2212 x 1659 pixels.
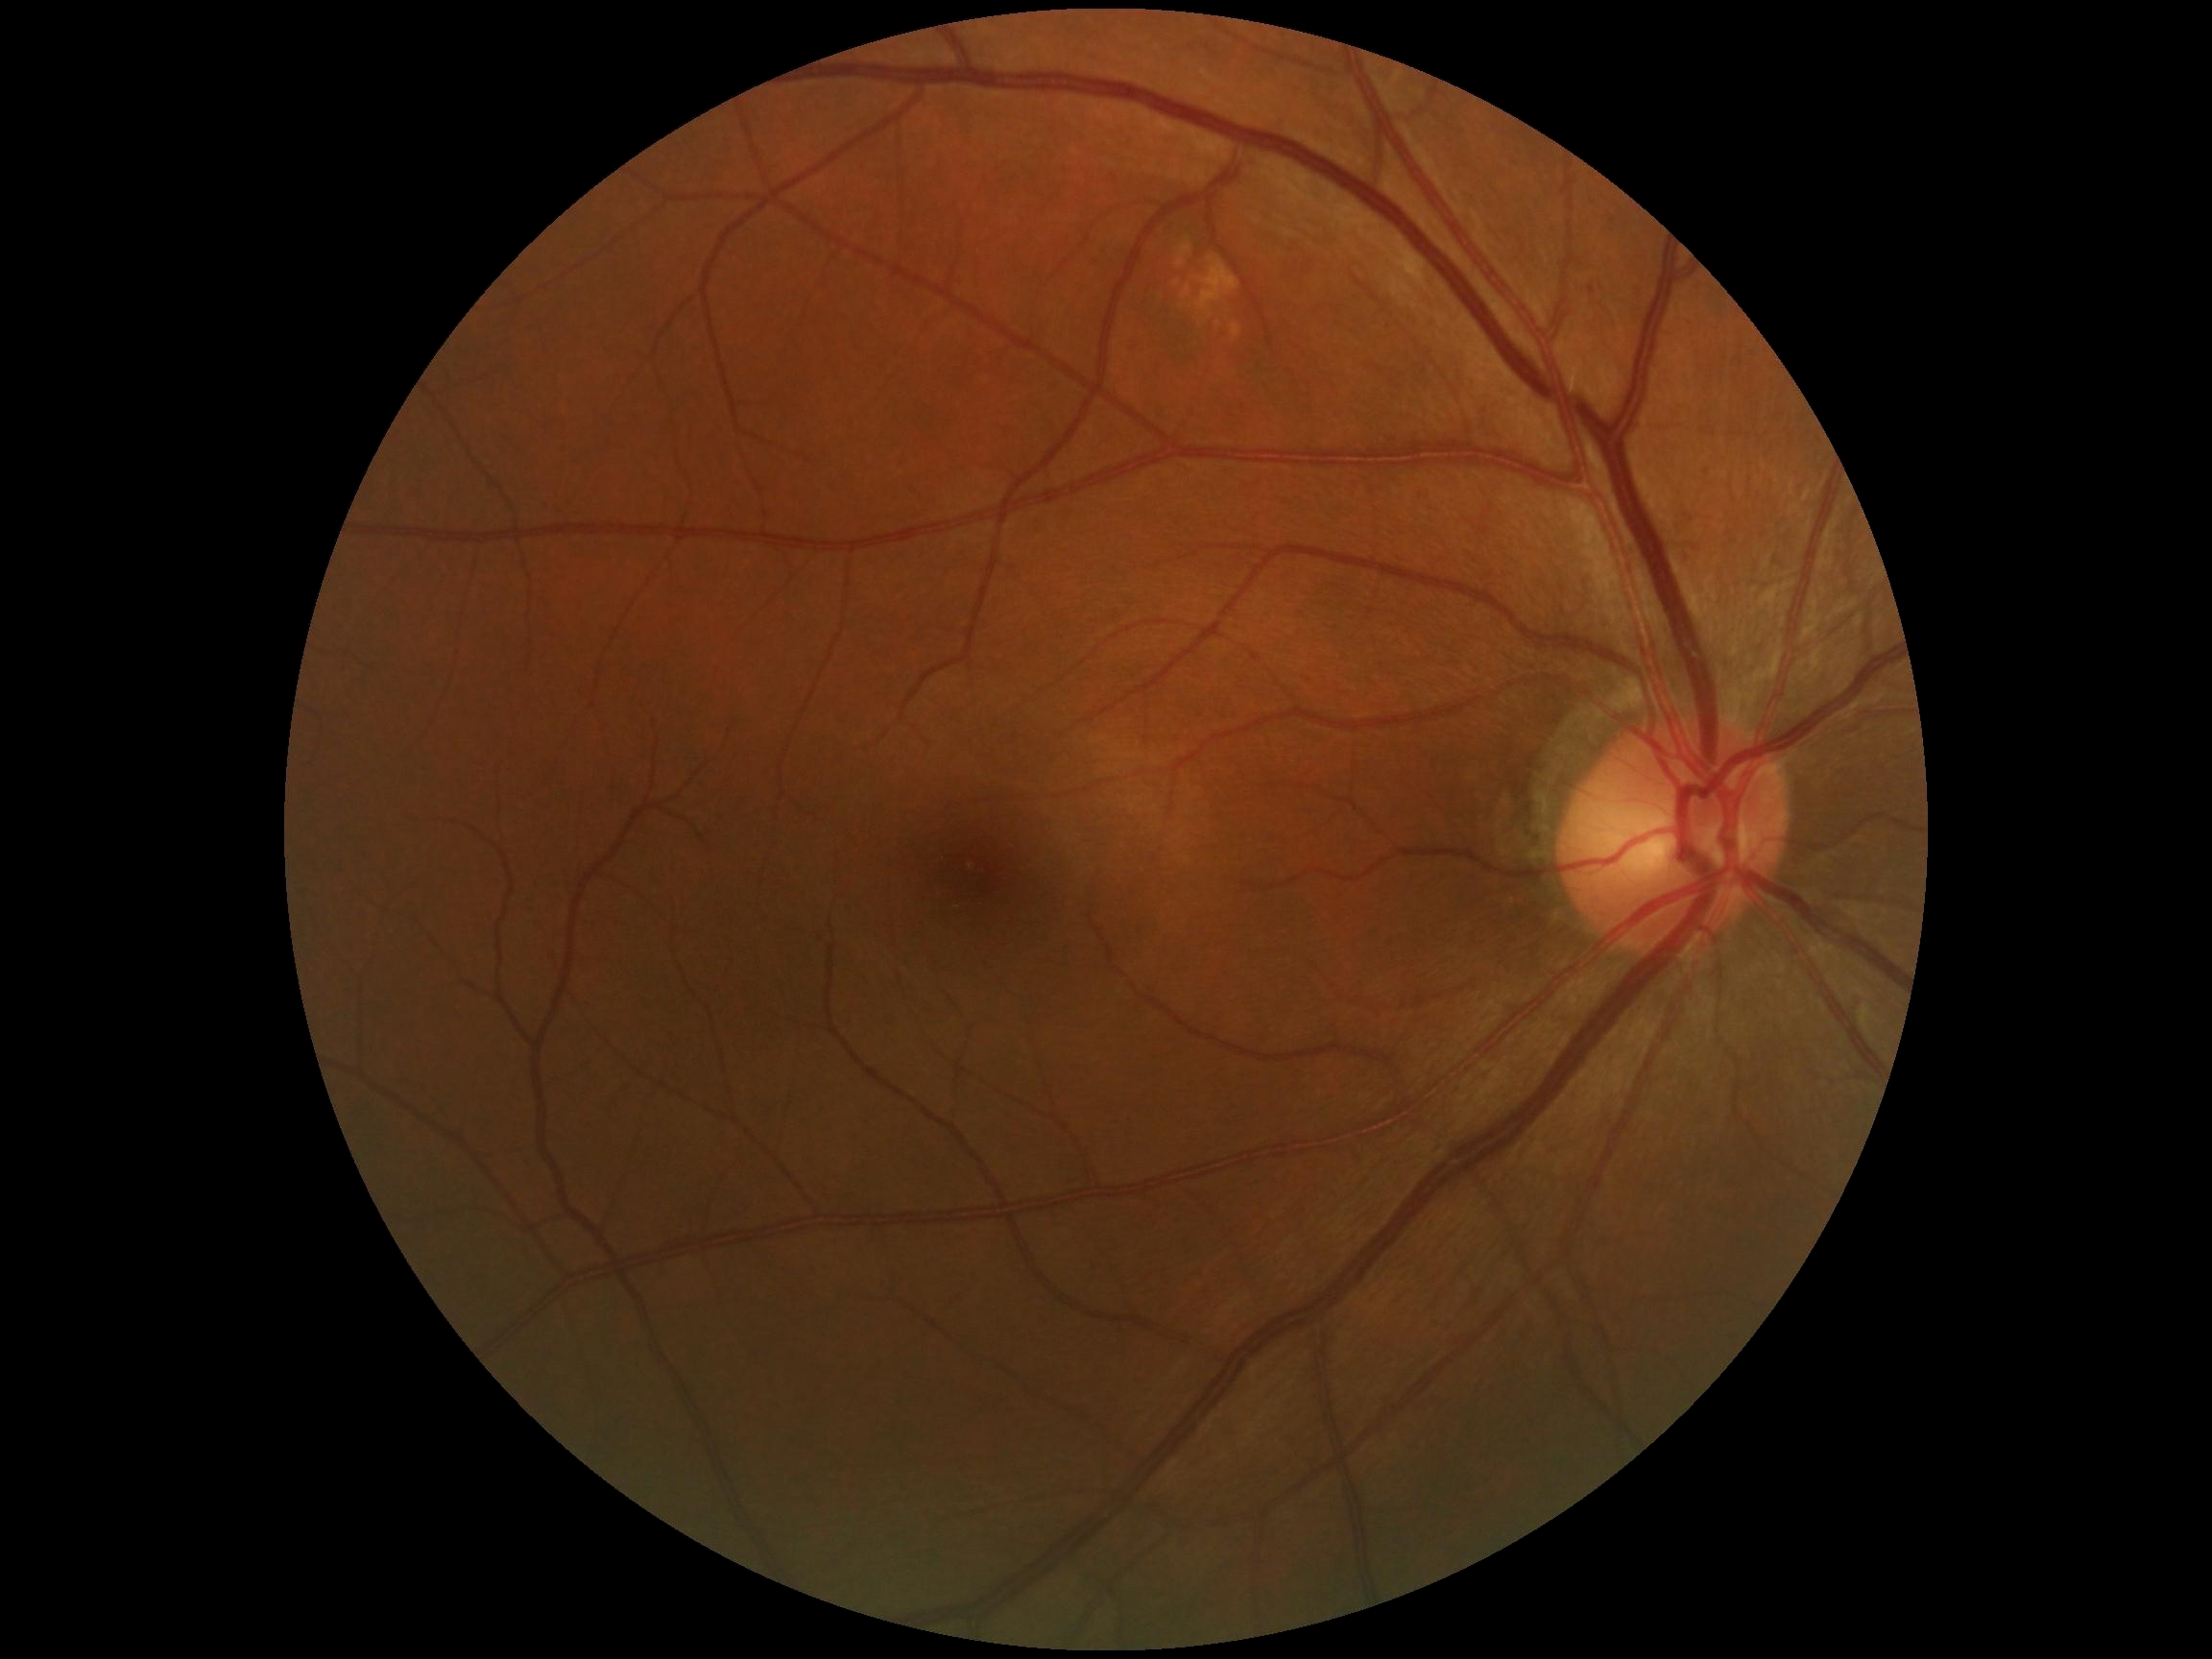

No diabetic retinal disease findings.
DR grade is 0.